Pediatric retinal photograph (wide-field) — 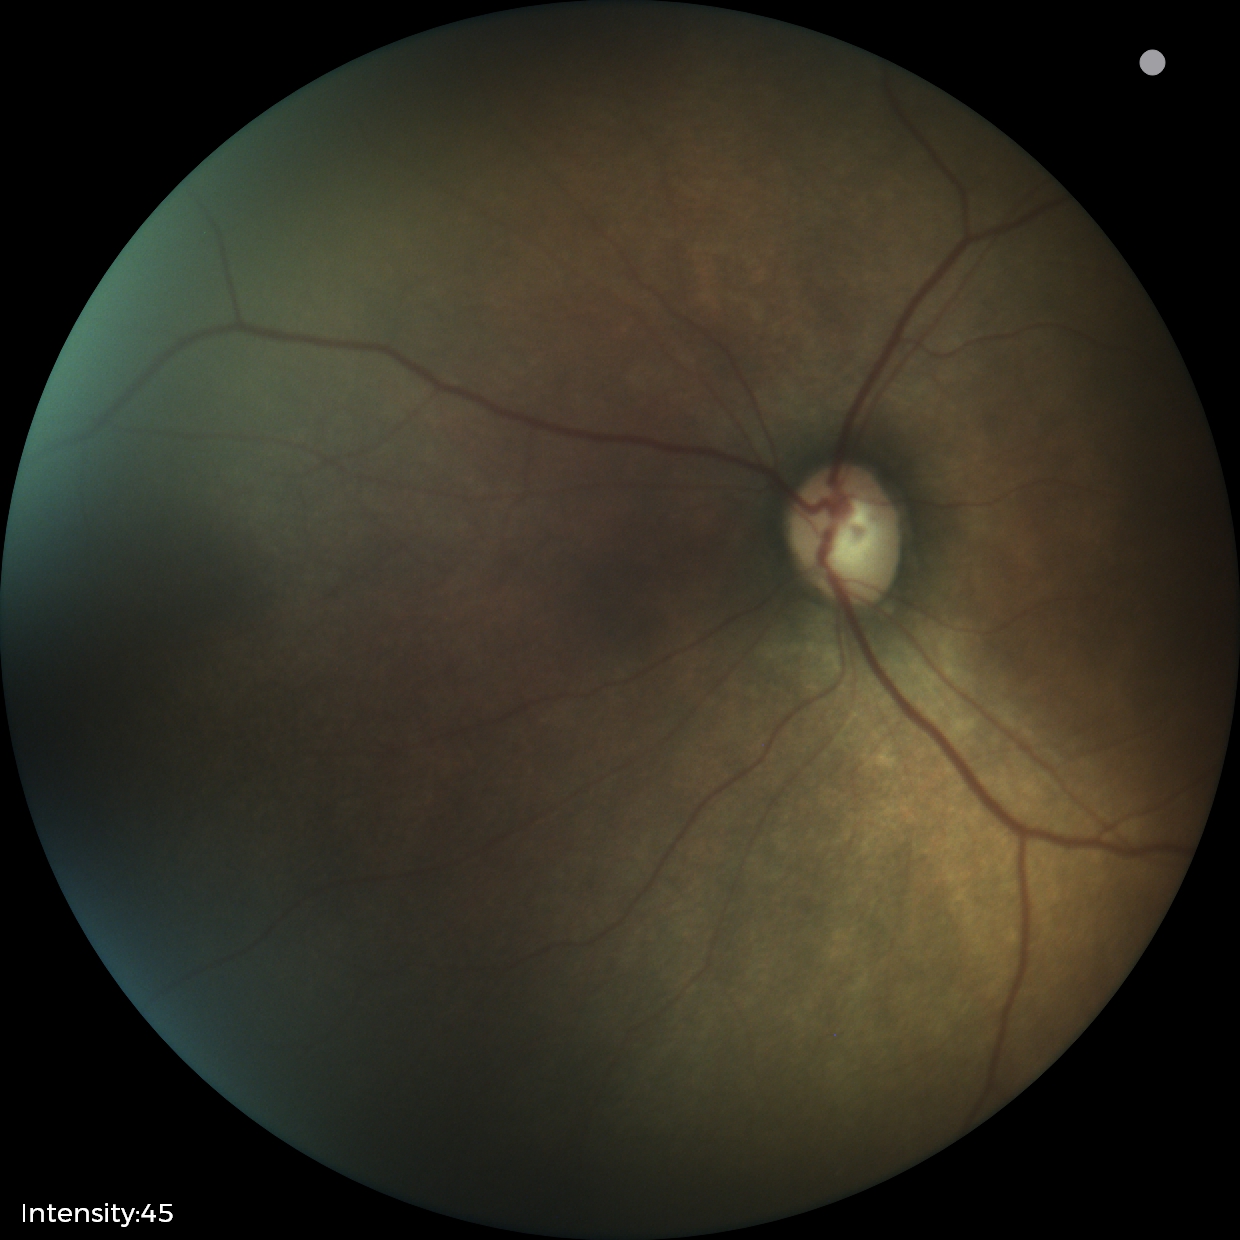
Screening examination consistent with status post retinopathy of prematurity.